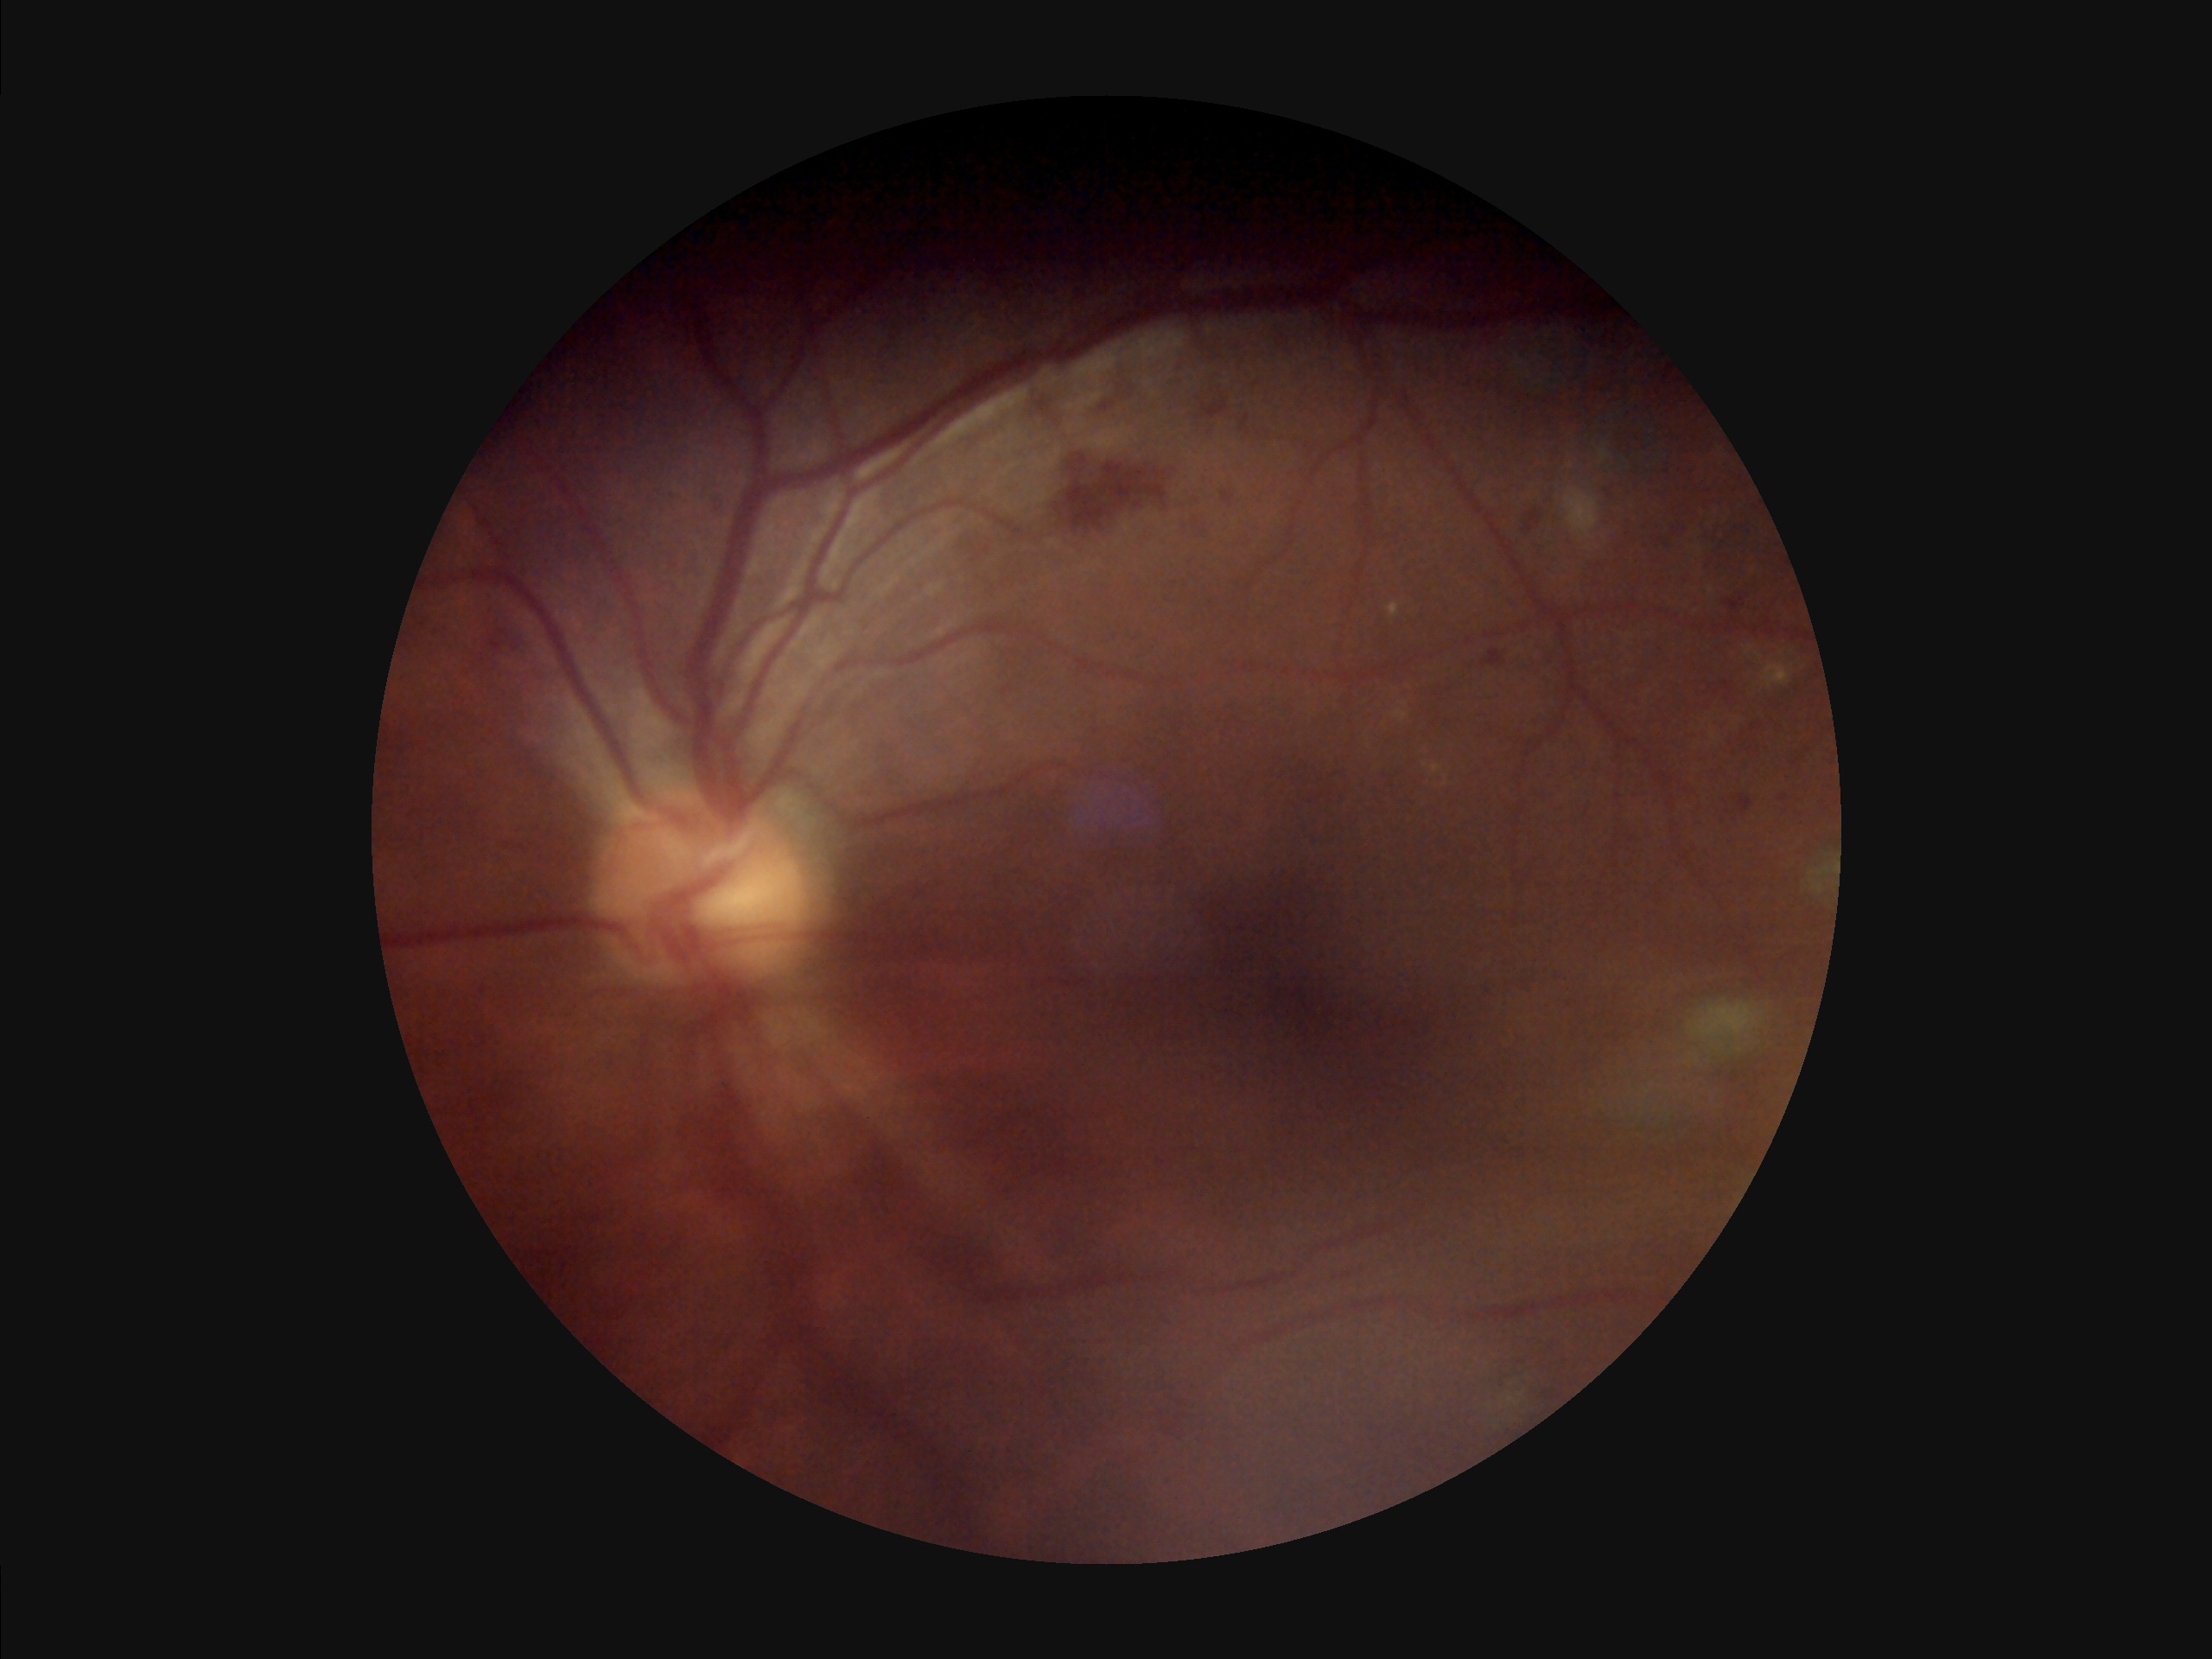 Overall quality is poor; the image is difficult to grade. Poor illumination with uneven exposure. Vessels and details are hard to distinguish. The image is blurry.